NIDEK AFC-230
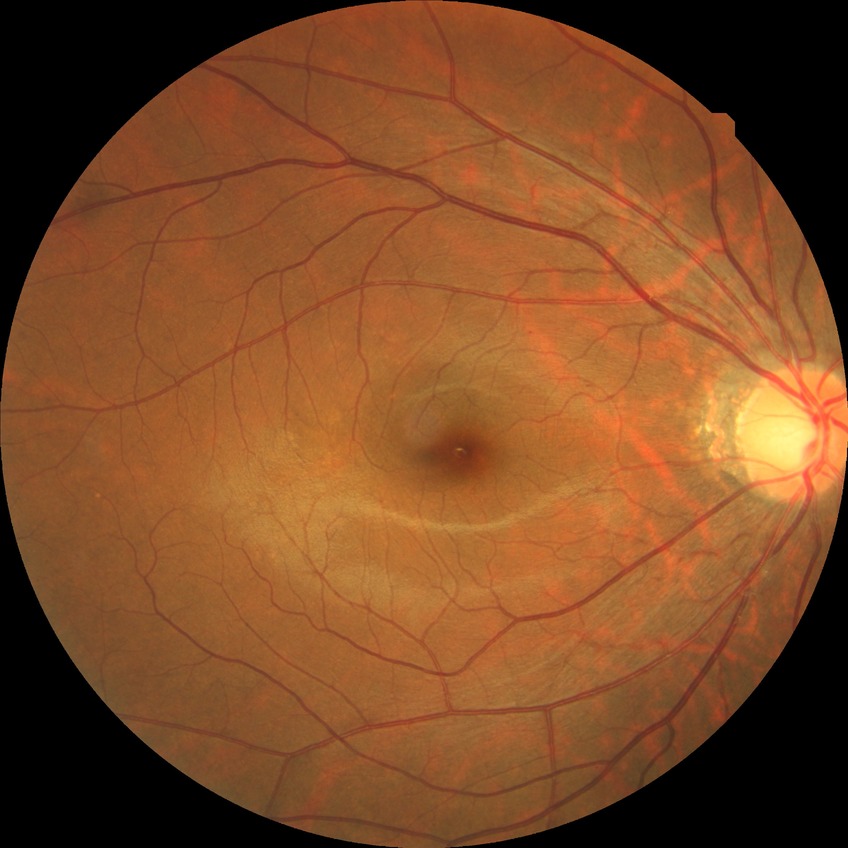 diabetic retinopathy (DR): SDR (simple diabetic retinopathy).